Kowa VX-10α, 50-degree field of view, image size 2361x1568, captured after pupil dilation:
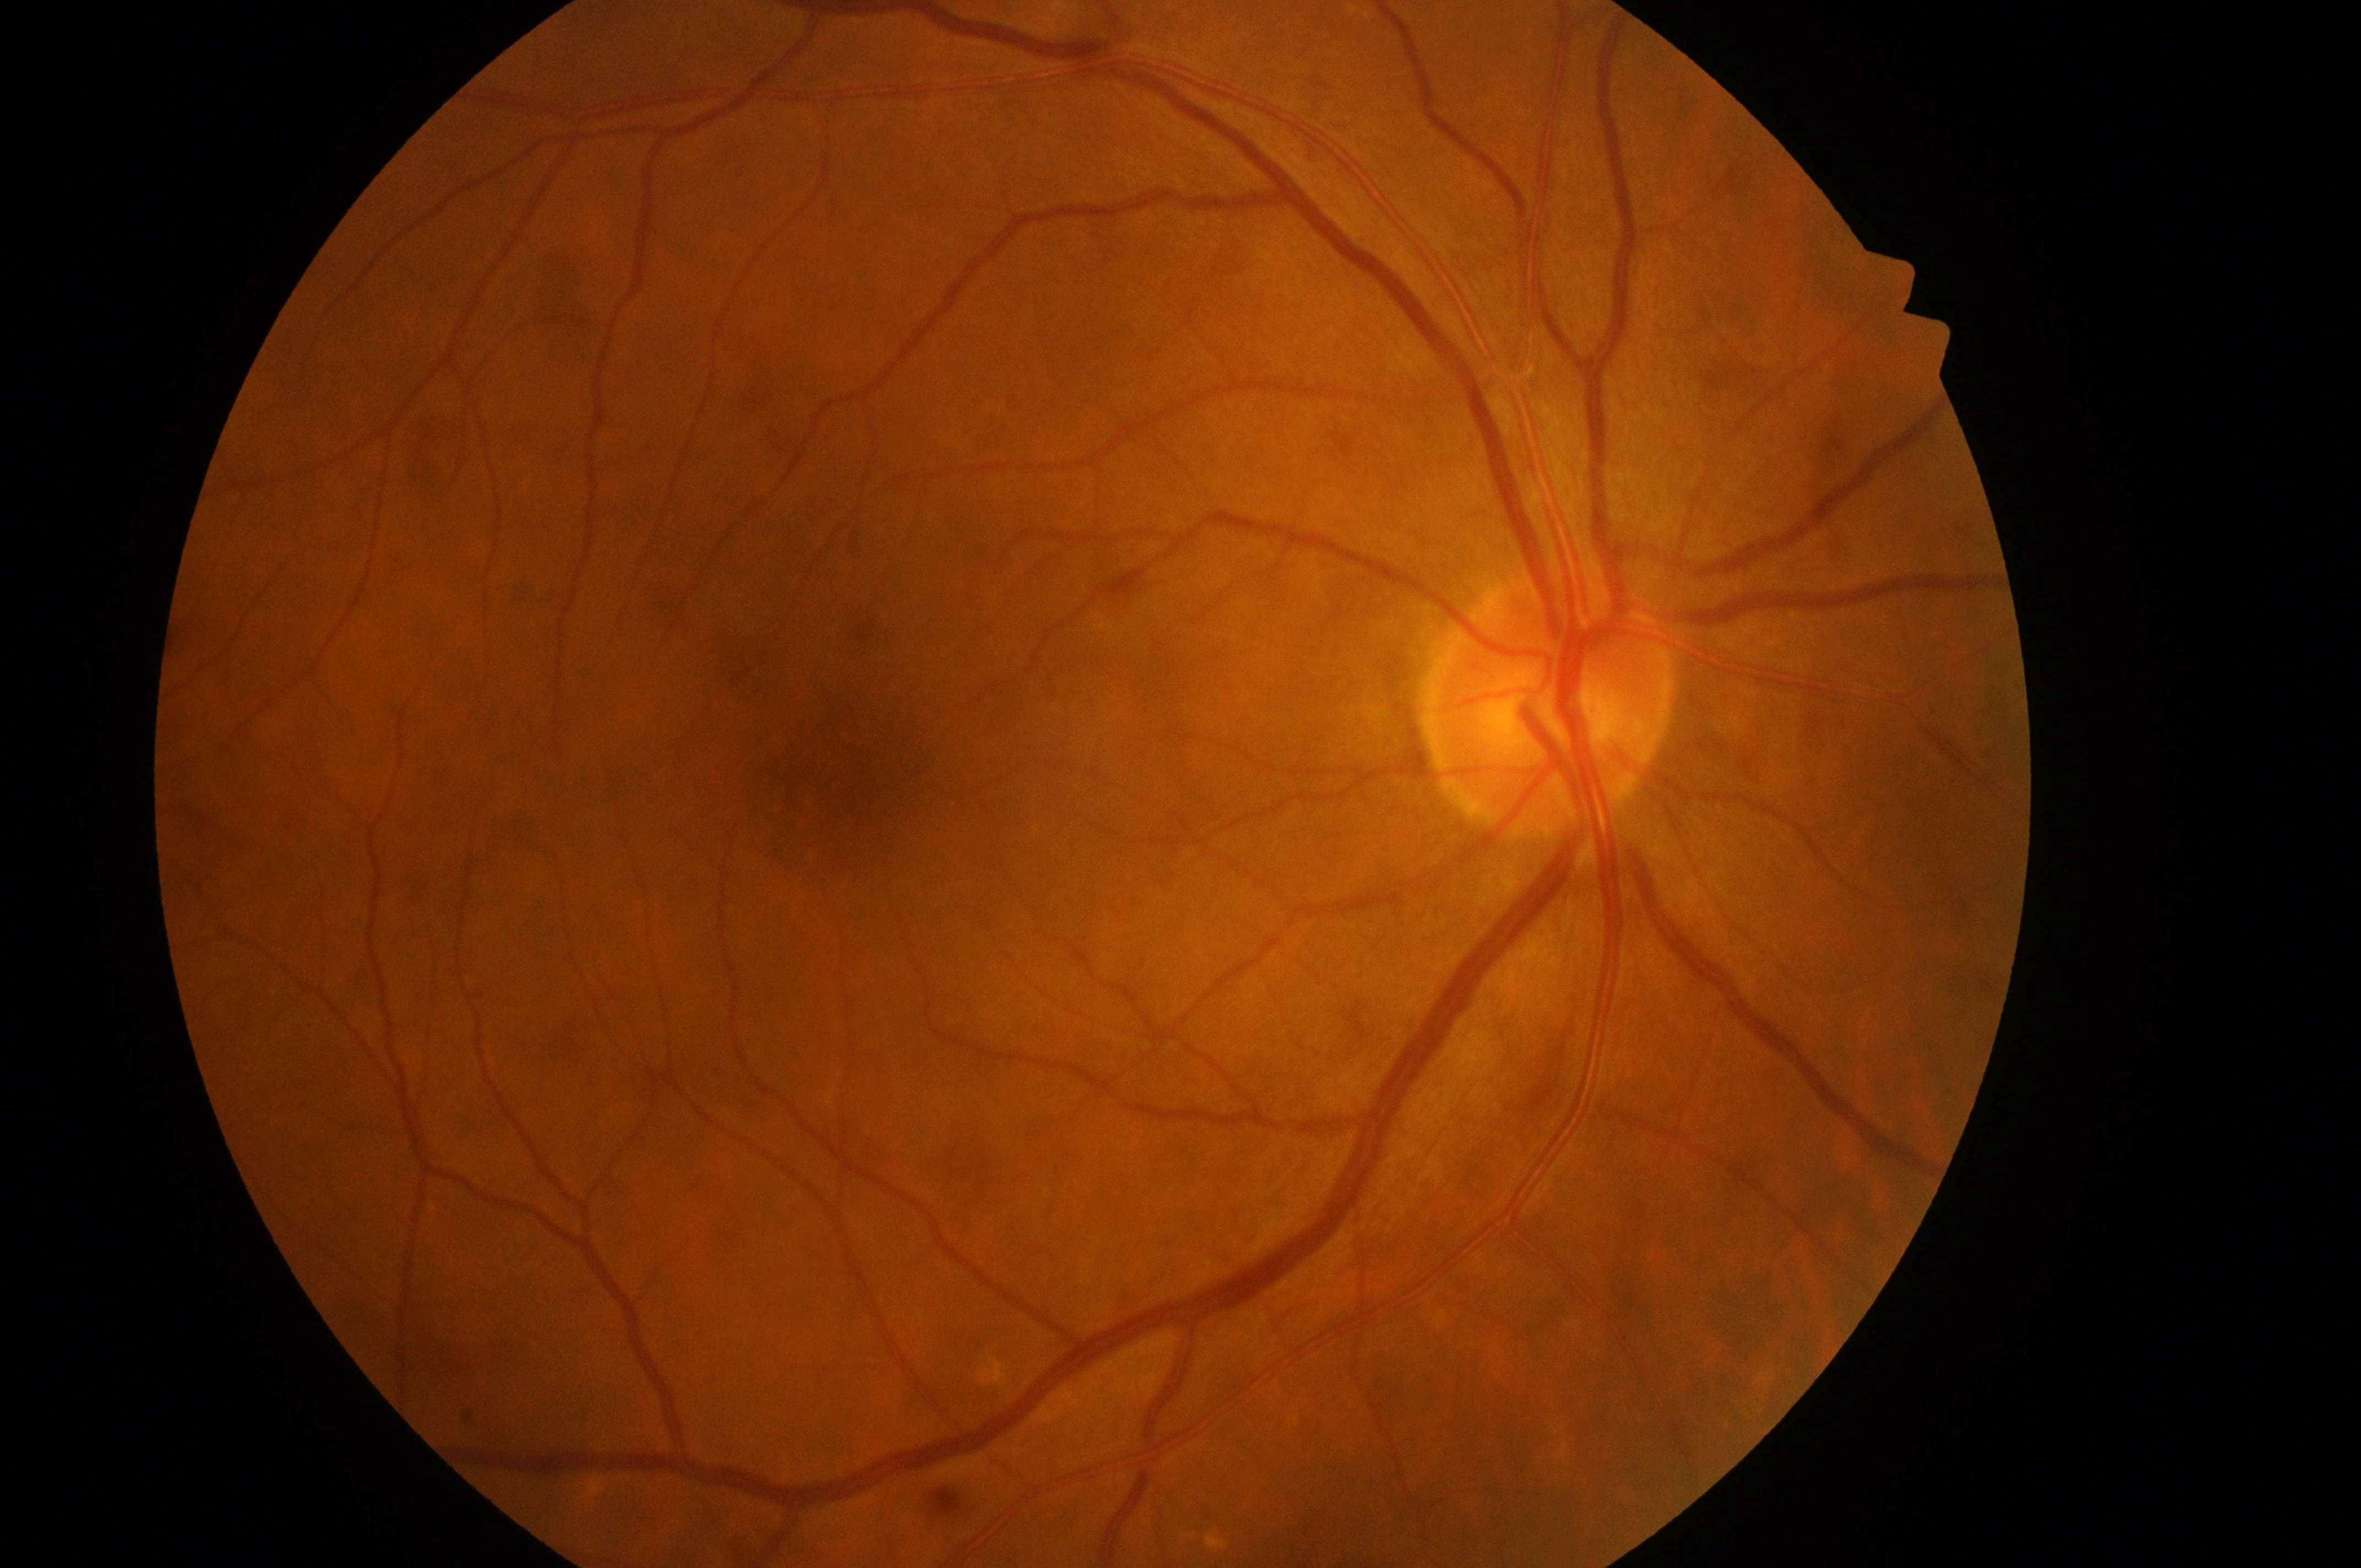 Macular center: (839,783). DME is no risk (grade 0) — no apparent hard exudates. Optic disc center located at (1547,717). DR severity is no apparent diabetic retinopathy (grade 0) — no visible signs of diabetic retinopathy. The image shows the right eye.